Infant wide-field retinal image.
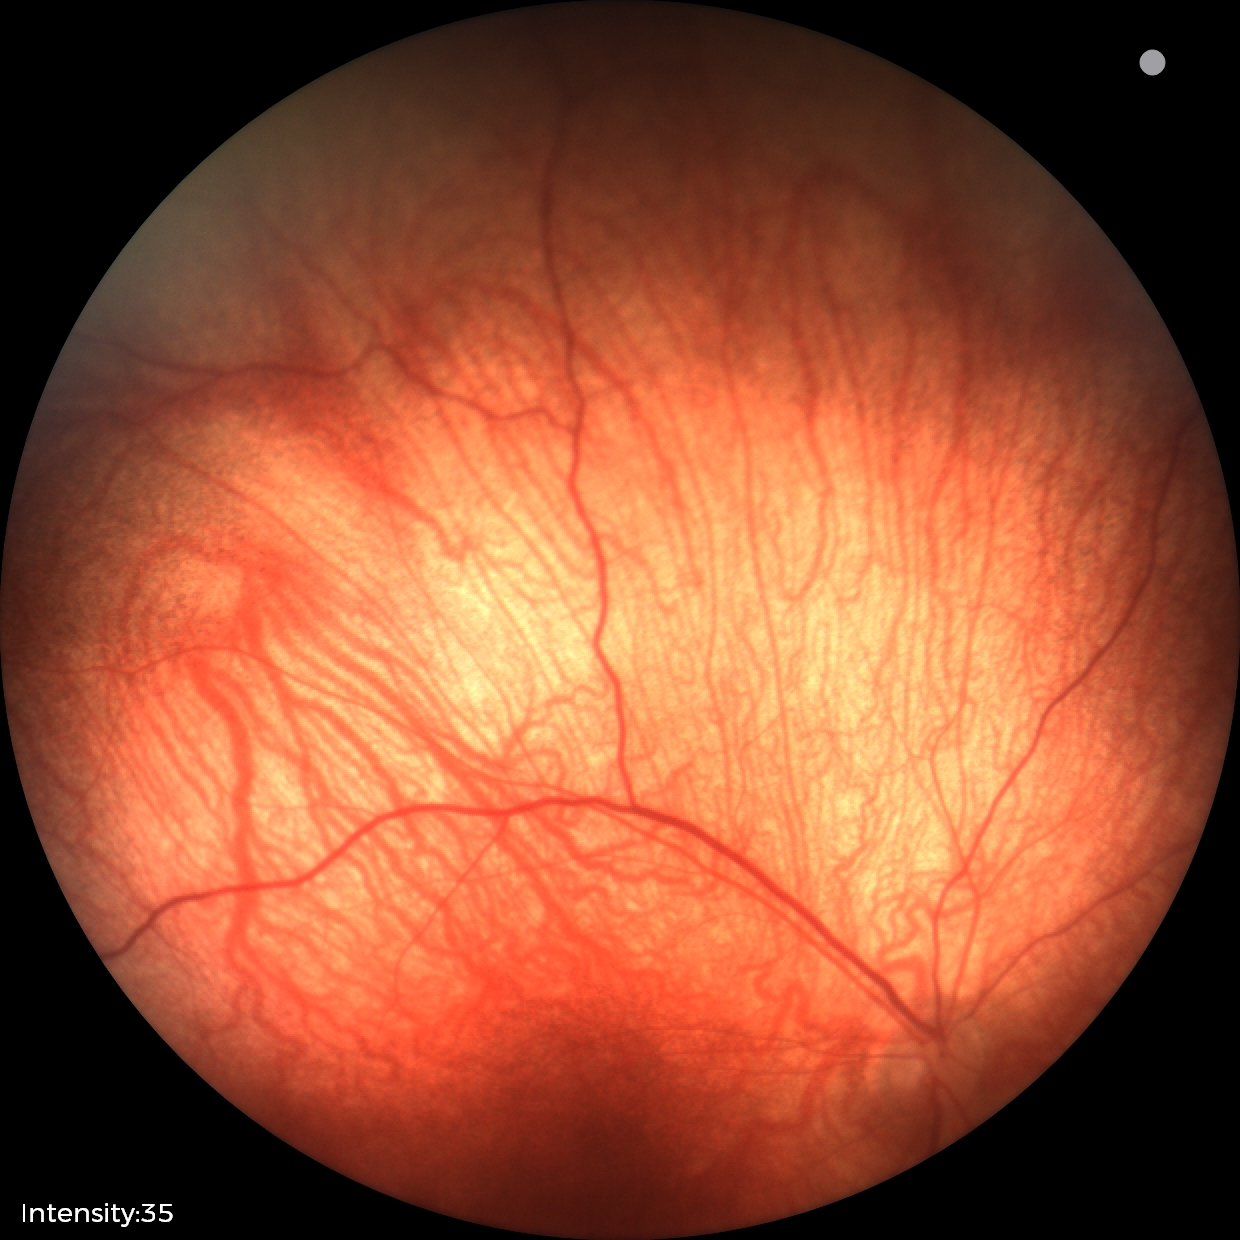 Normal screening examination.